45° FOV:
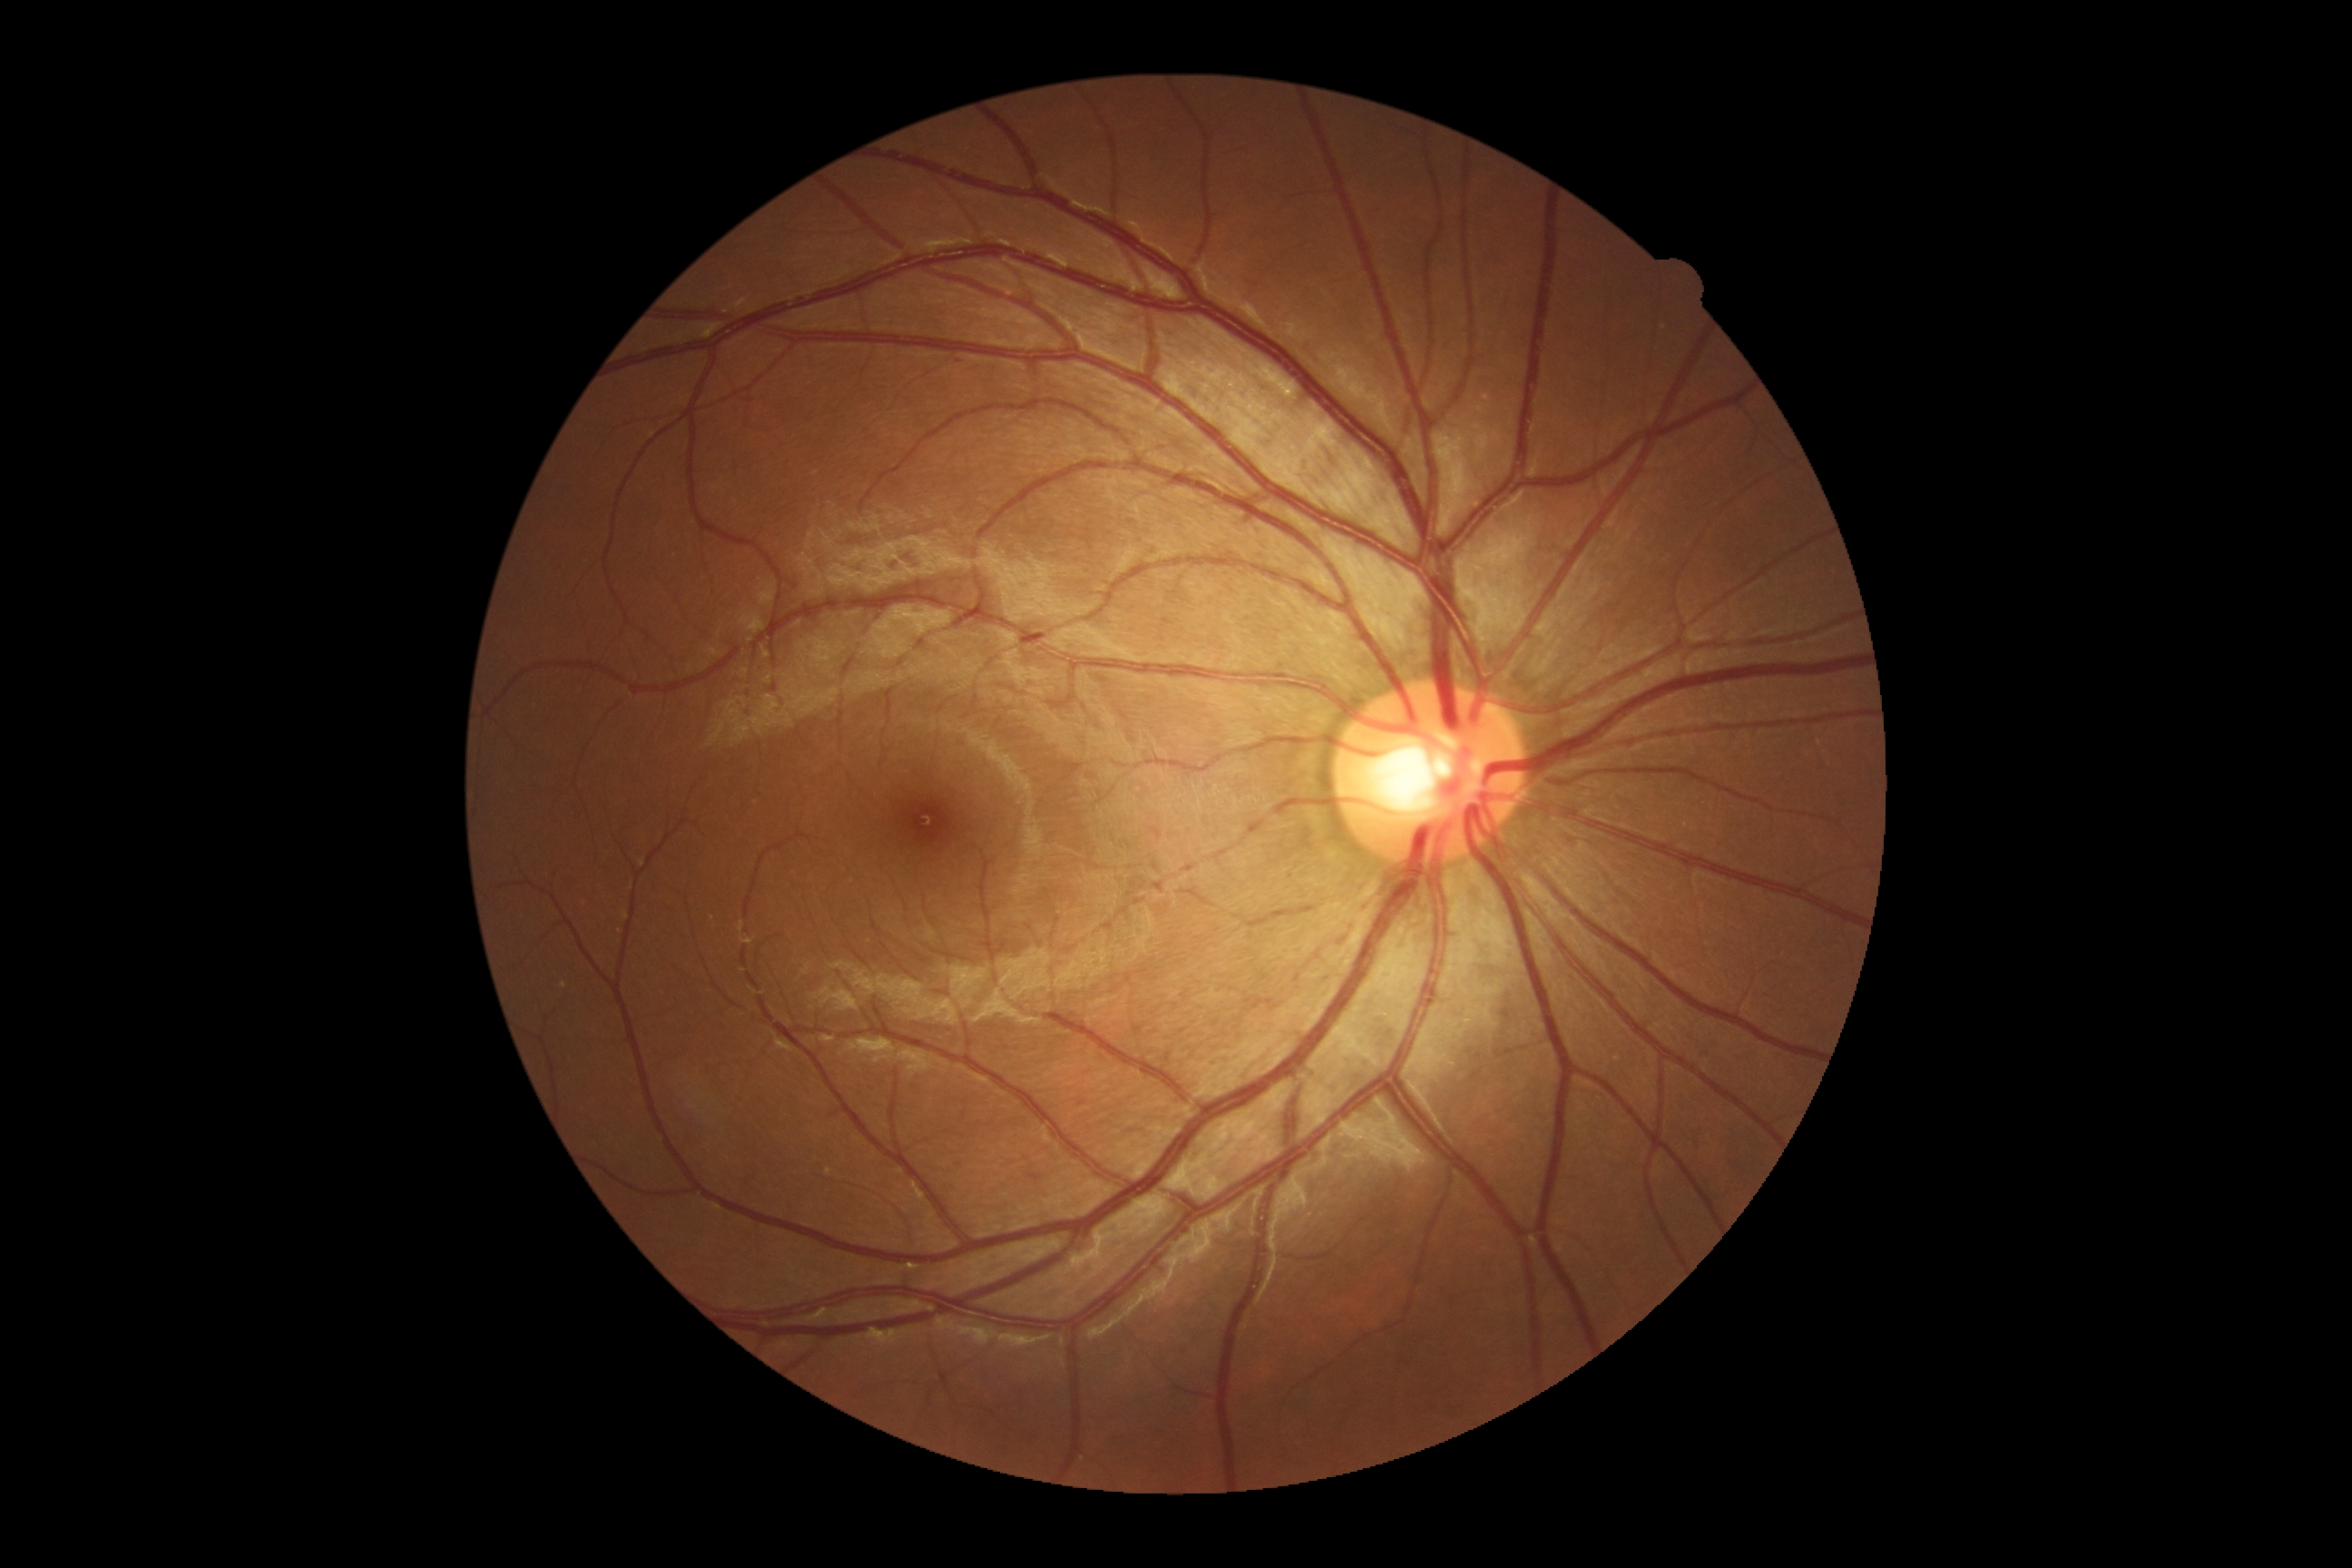

DR grade is 0.